45° FOV: 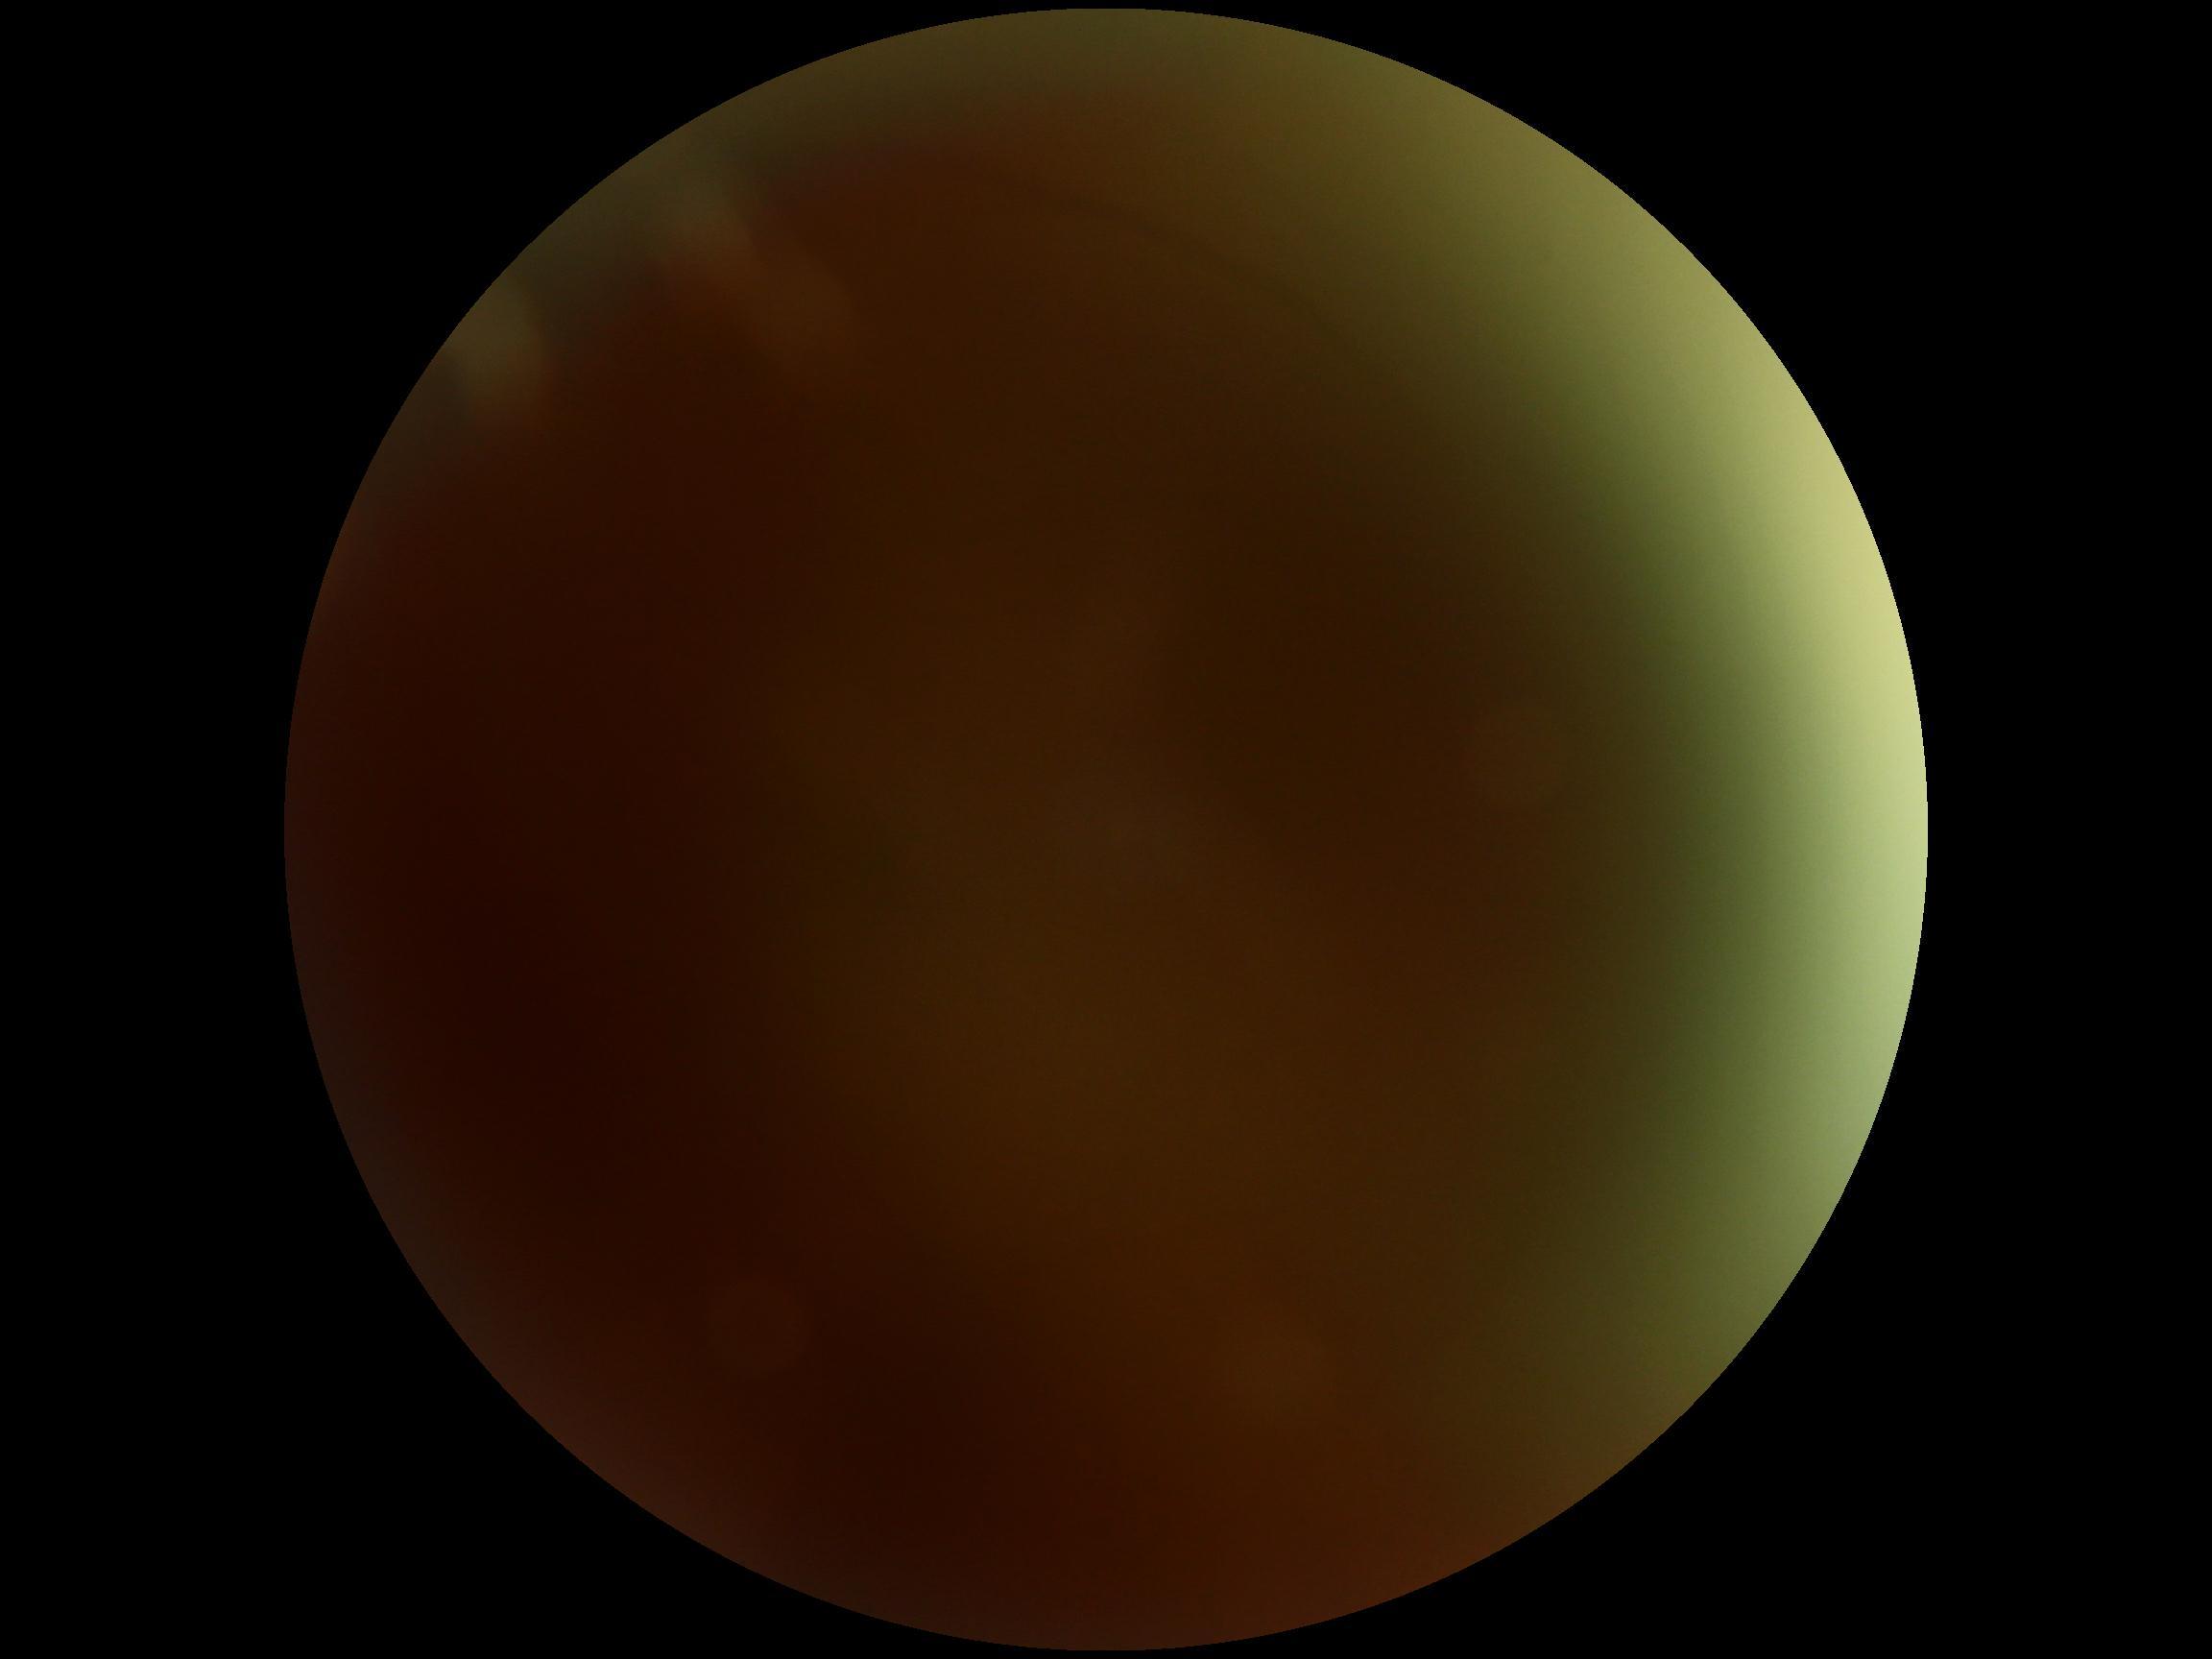 Findings:
* diabetic retinopathy grade: ungradable due to poor image quality
* image quality: insufficient